Image size 1932x1916, 45° field of view:
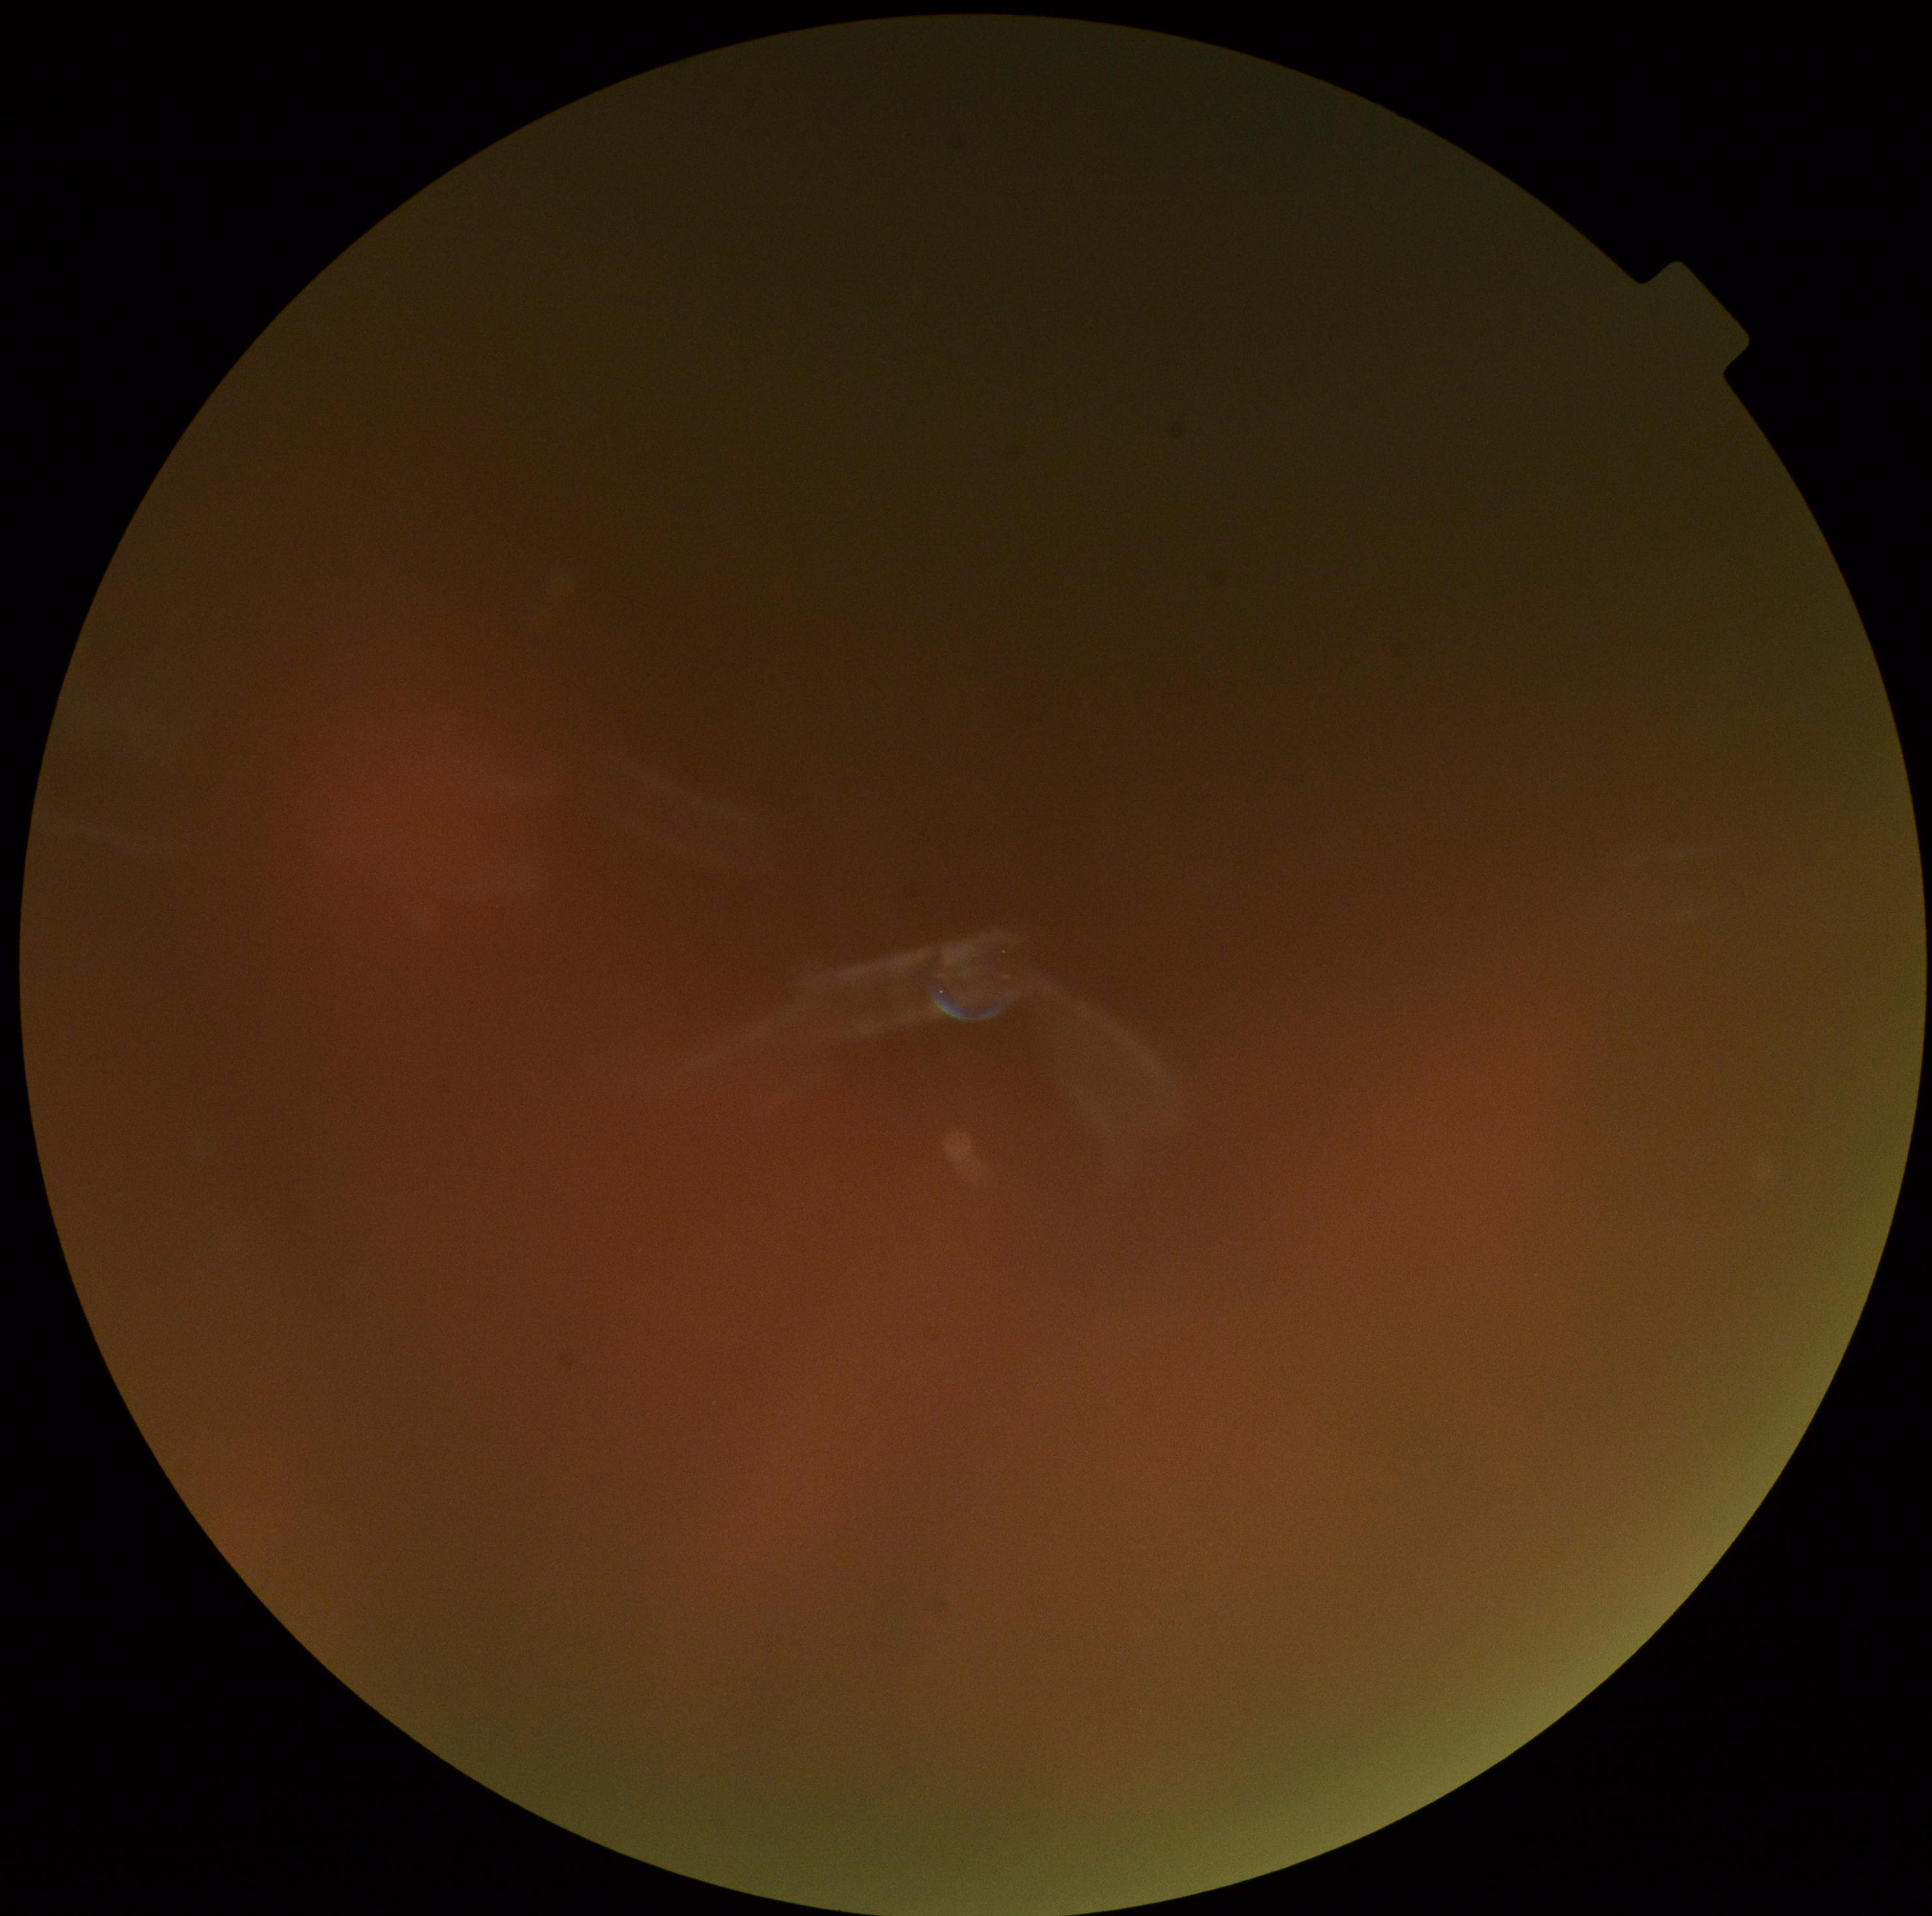 • diabetic retinopathy grade — ungradable due to poor image quality